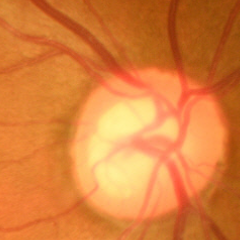 Optic disc photograph demonstrating no signs of glaucoma.